Wide-field fundus photograph of an infant; 640x480px
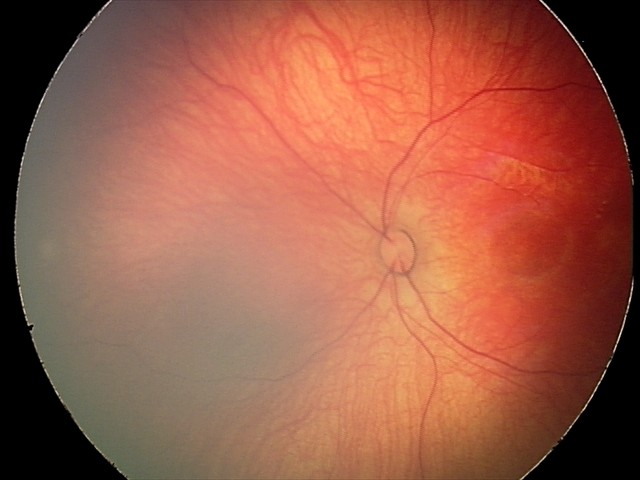
Assessment: retinal hemorrhages.